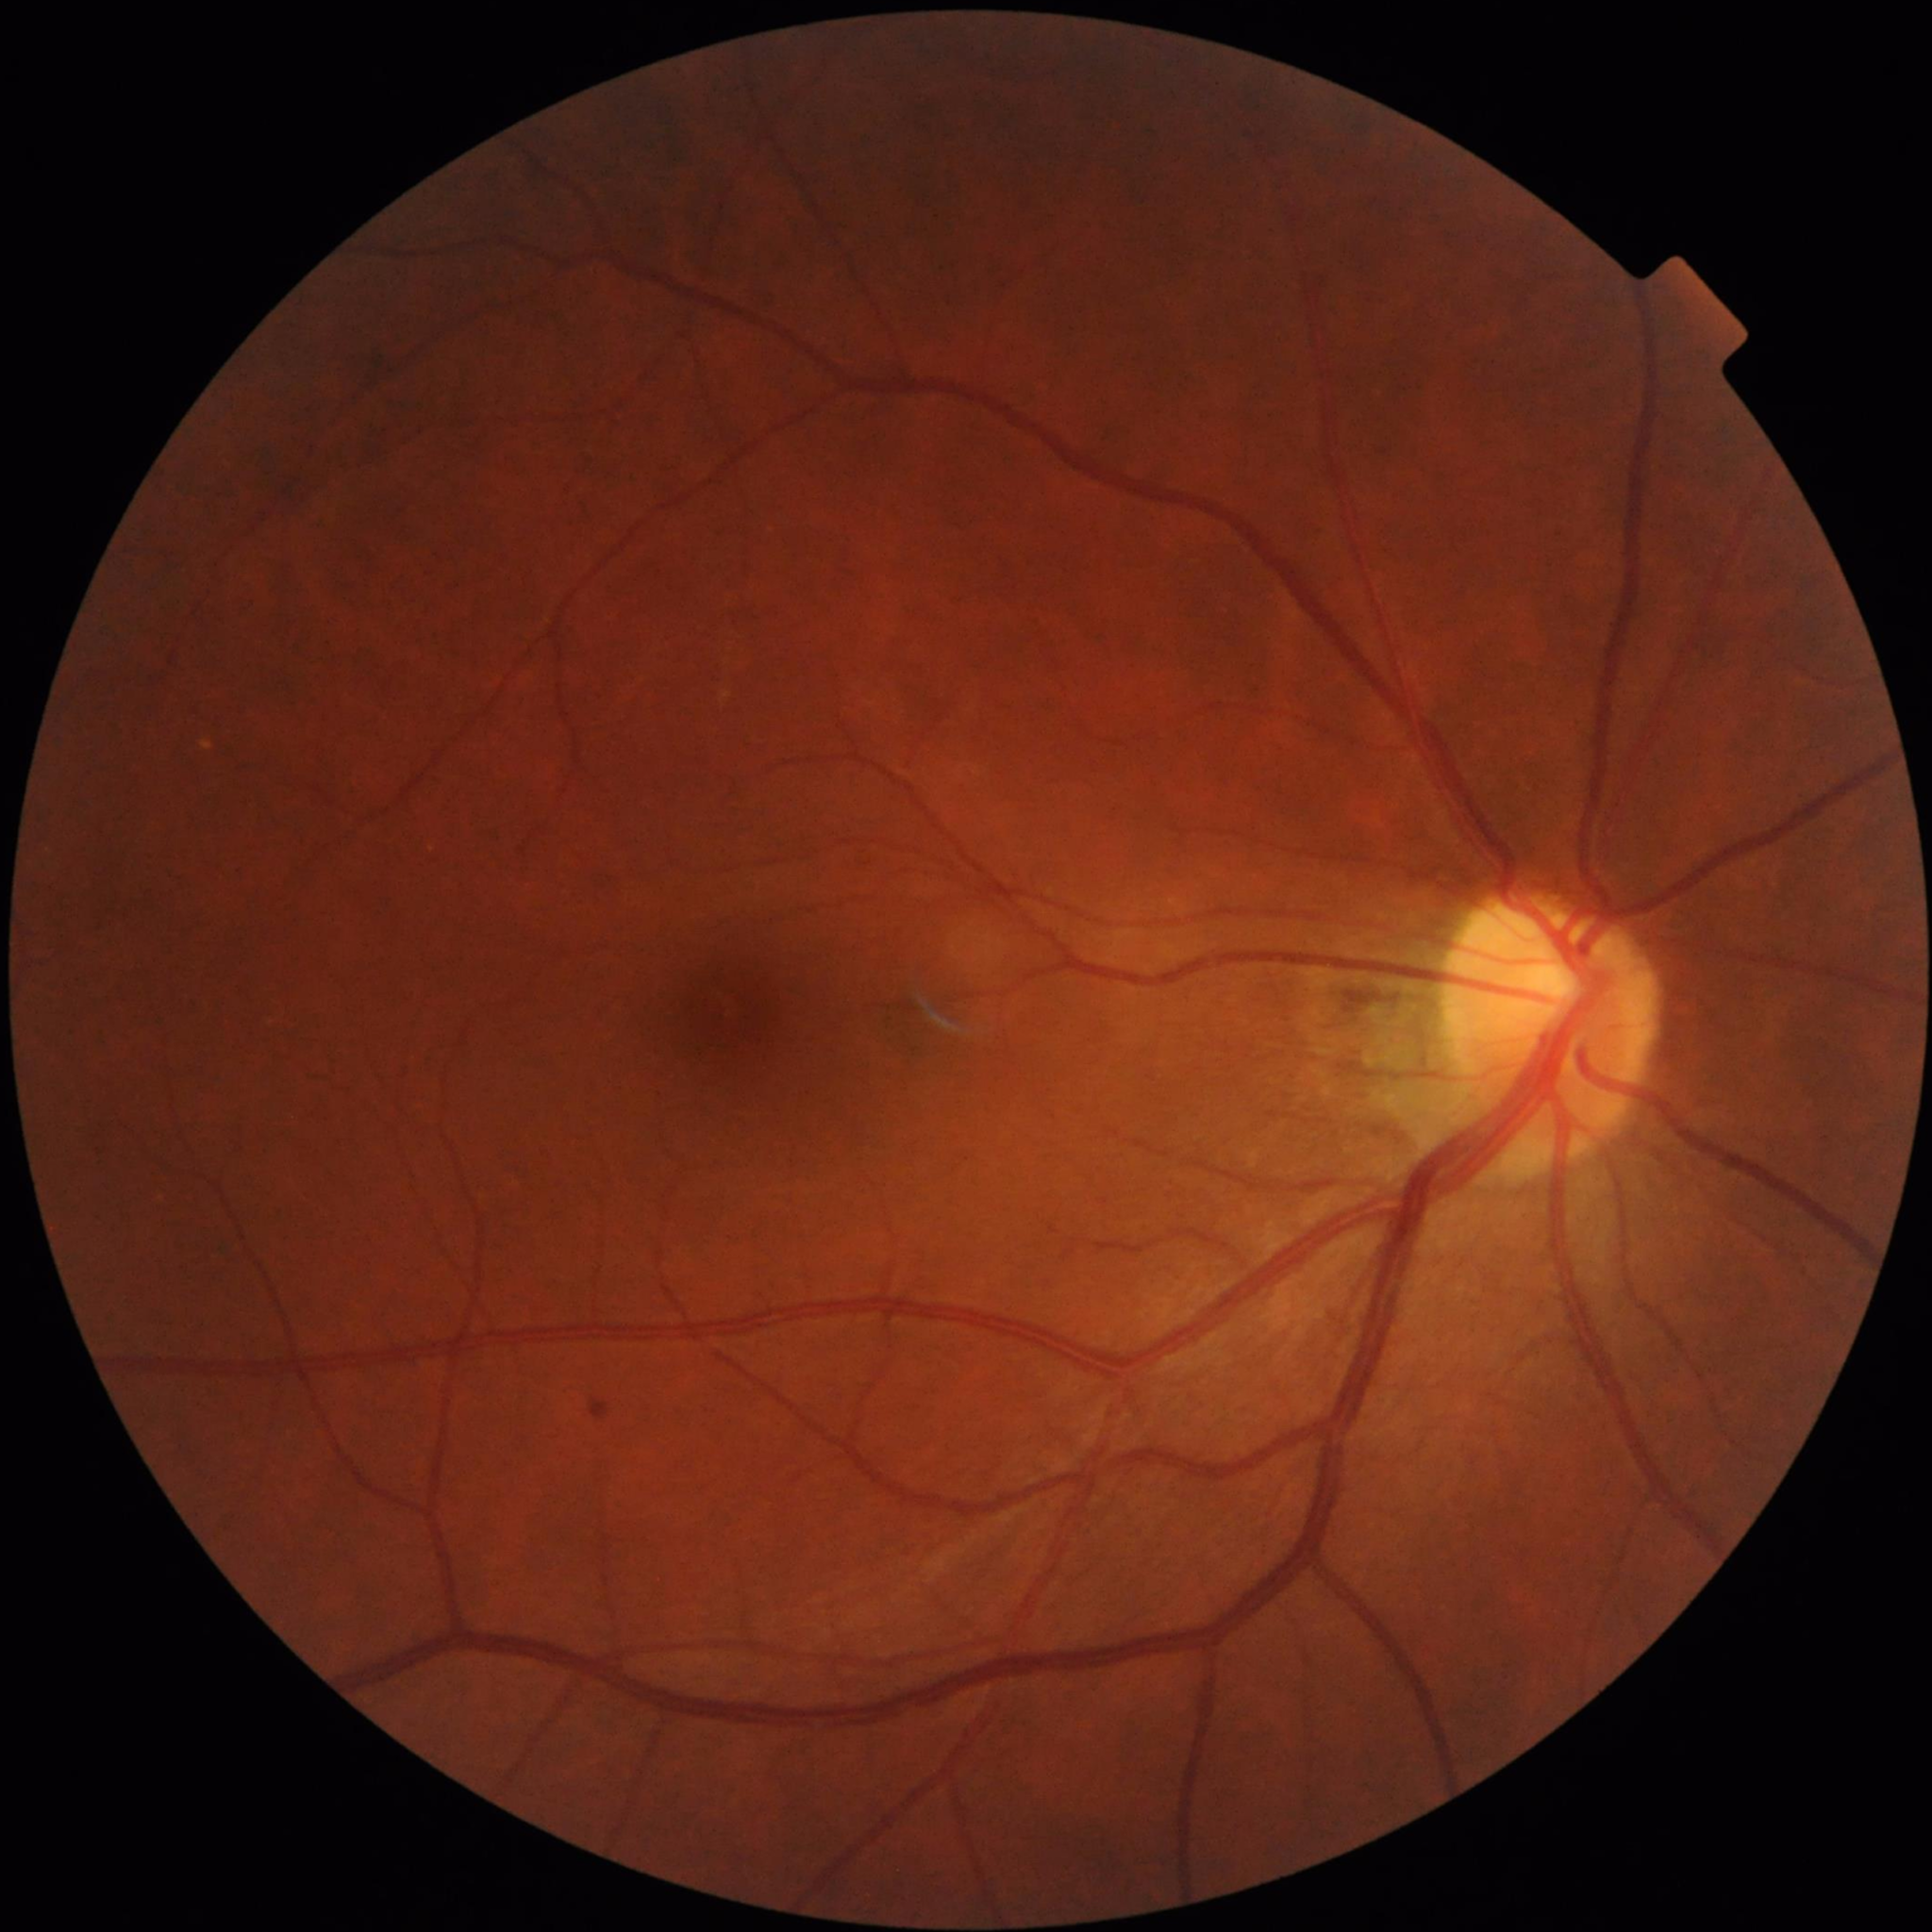
Color fundus photograph with no signs of AMD, diabetic retinopathy, or glaucoma.